Phoenix ICON, 100° FOV; 1240x1240px; Phoenix ICON wide-field infant fundus image — 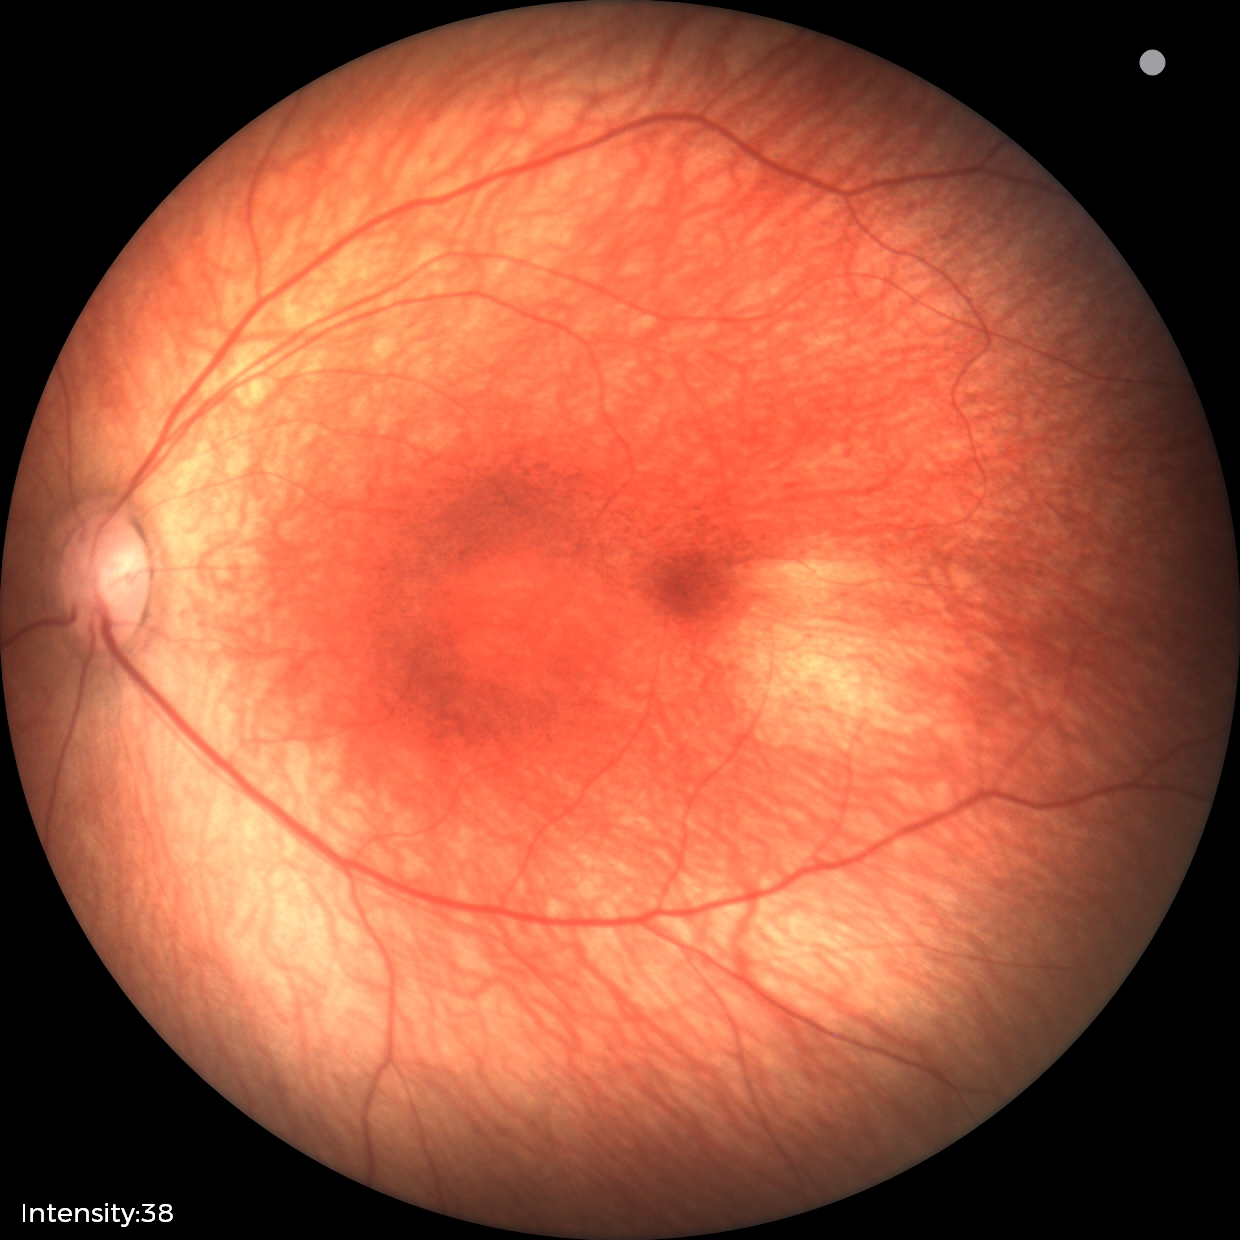
Assessment: physiological finding.